45 degree fundus photograph · modified Davis grading · posterior pole photograph · camera: NIDEK AFC-230.
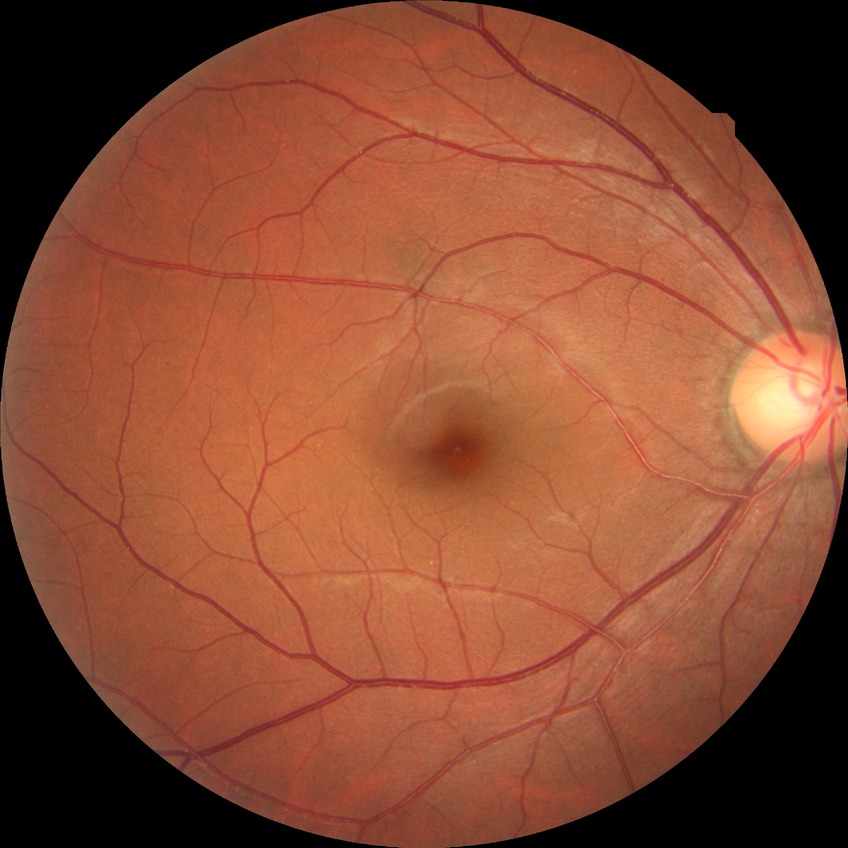 Modified Davis classification is no diabetic retinopathy.